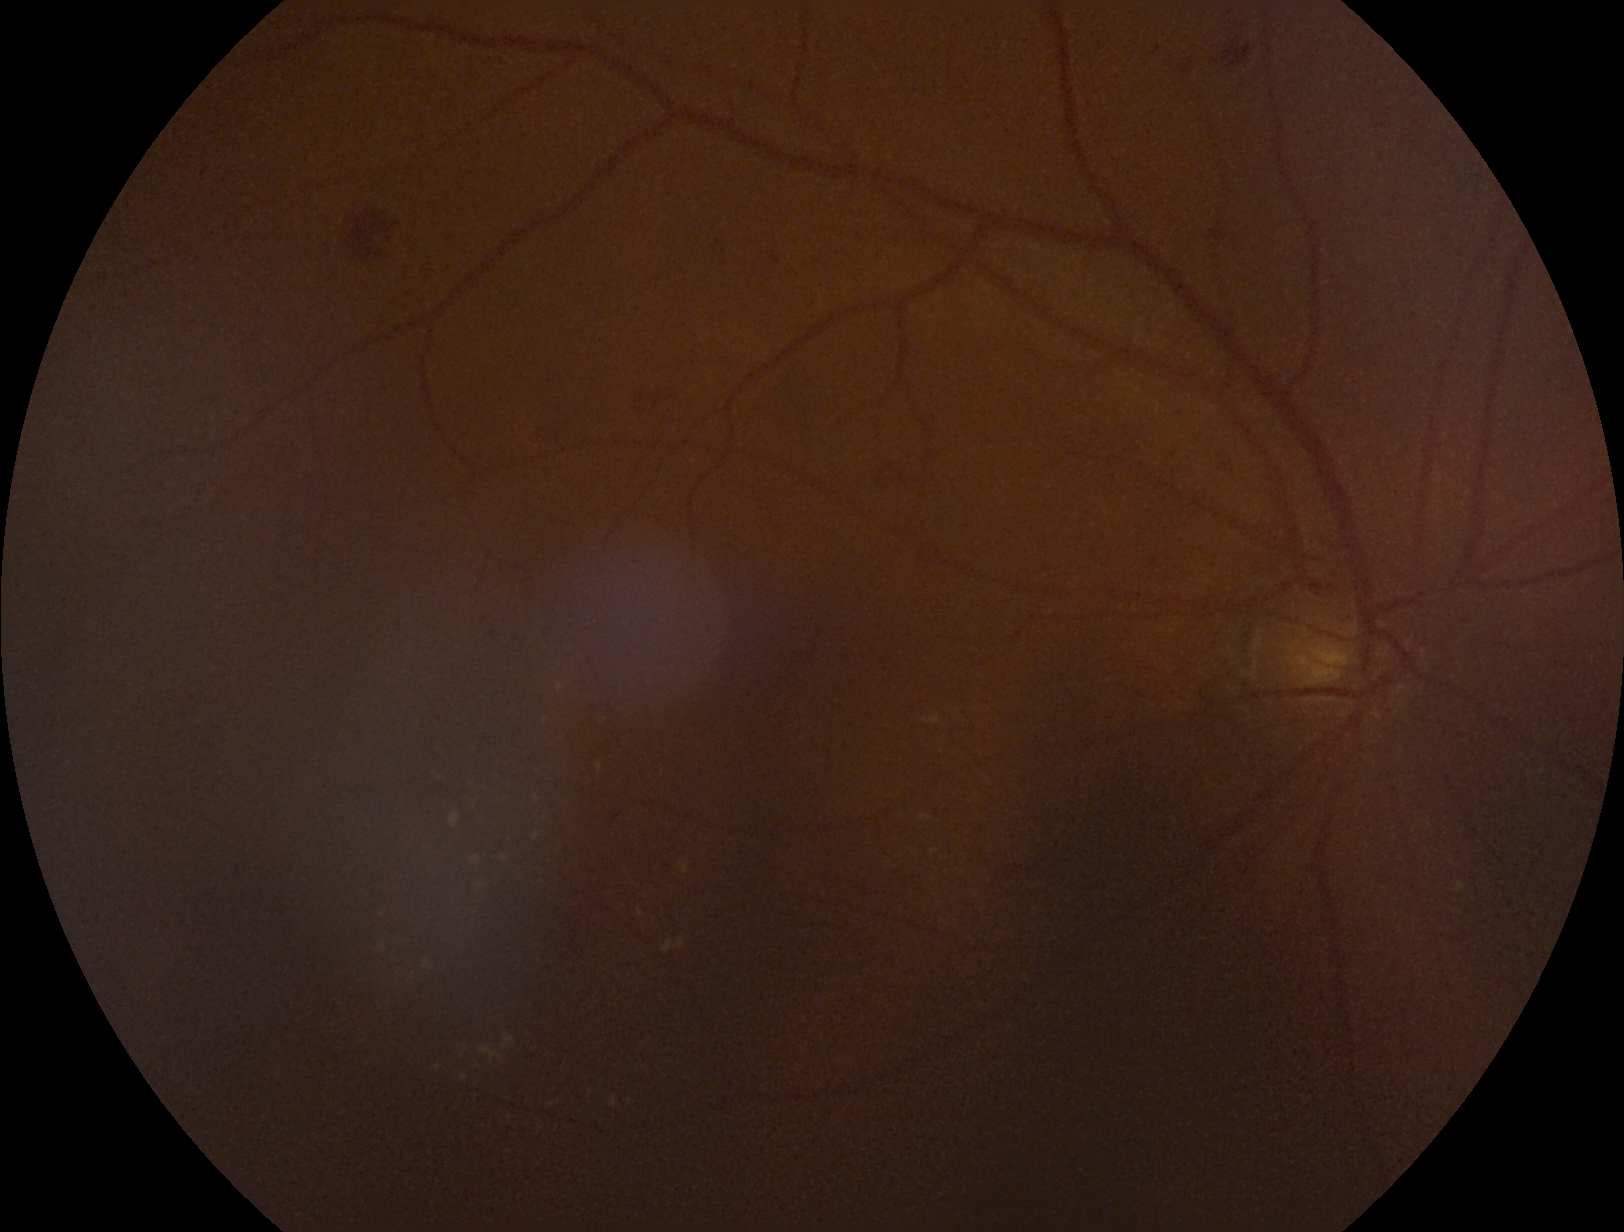 DR grade: 2 (moderate NPDR) — more than just microaneurysms but less than severe NPDR.